Color fundus photograph.
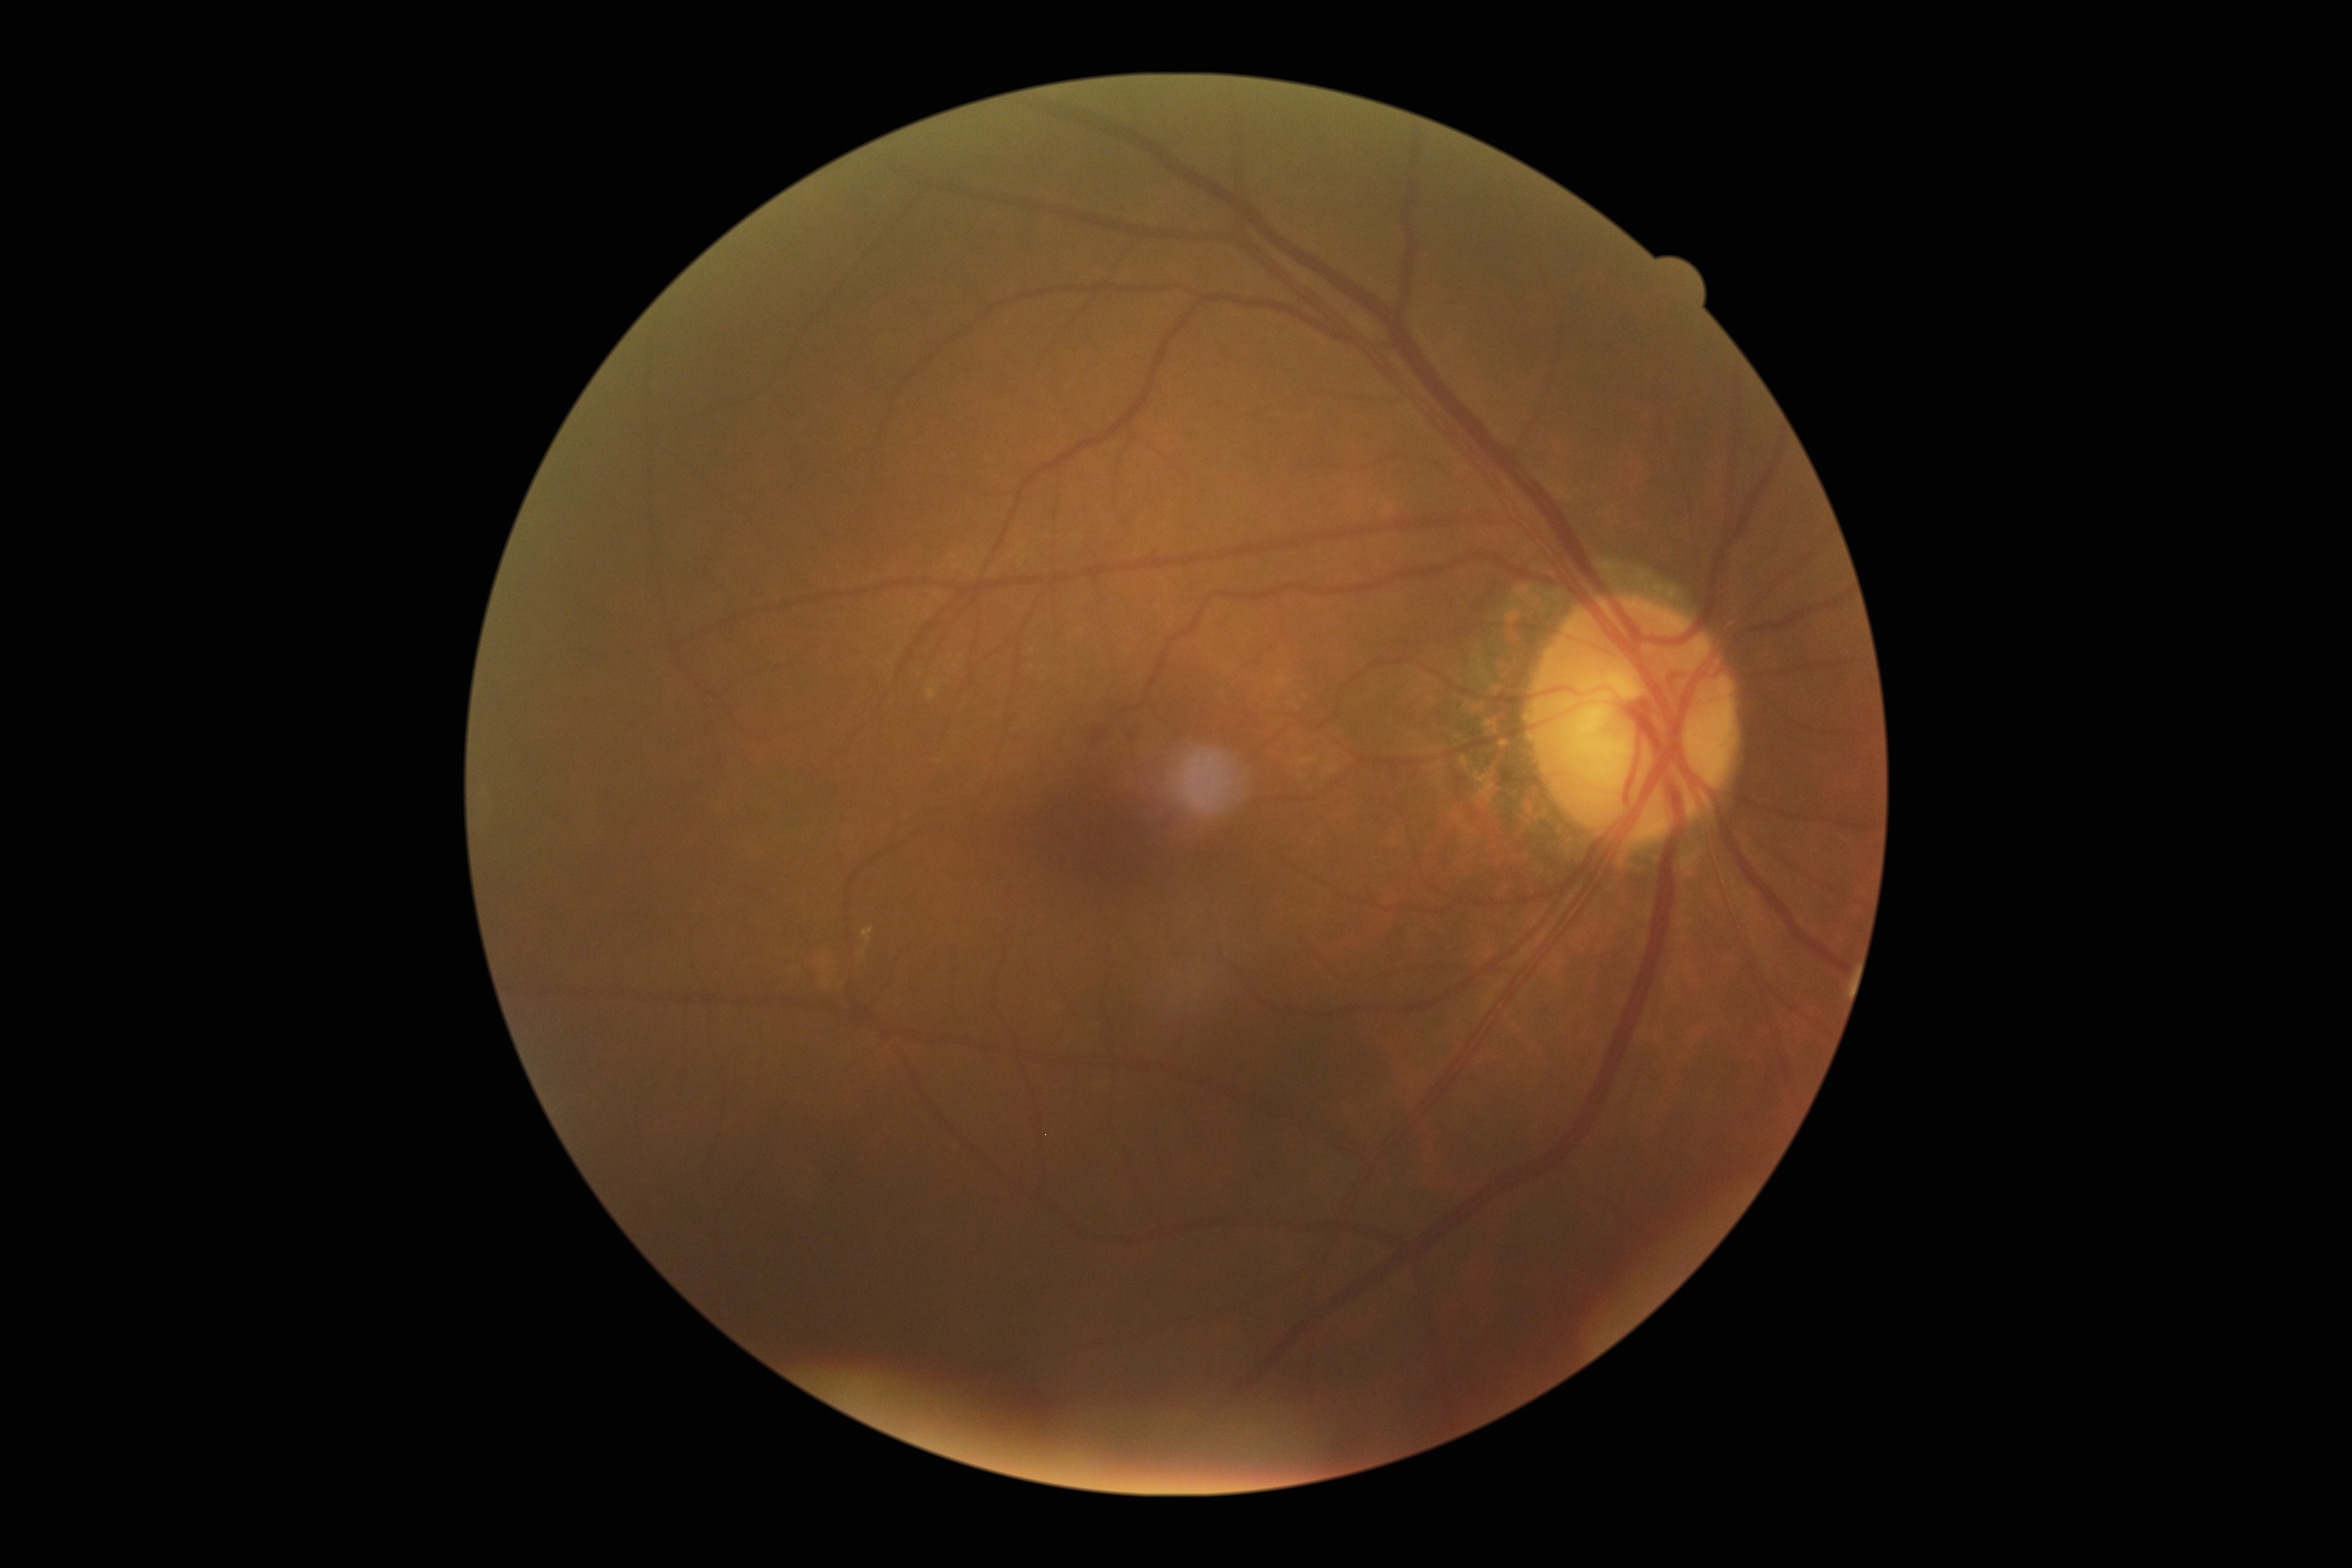

DR stage: moderate NPDR (grade 2)
SEs: none detected
HEs: none detected
MAs: 1093/729/1108/746; 1129/731/1137/740
EXs: 862/927/873/943
Small EXs near 863, 953